Pediatric wide-field fundus photograph. Camera: Phoenix ICON (100° FOV). 1240x1240px.
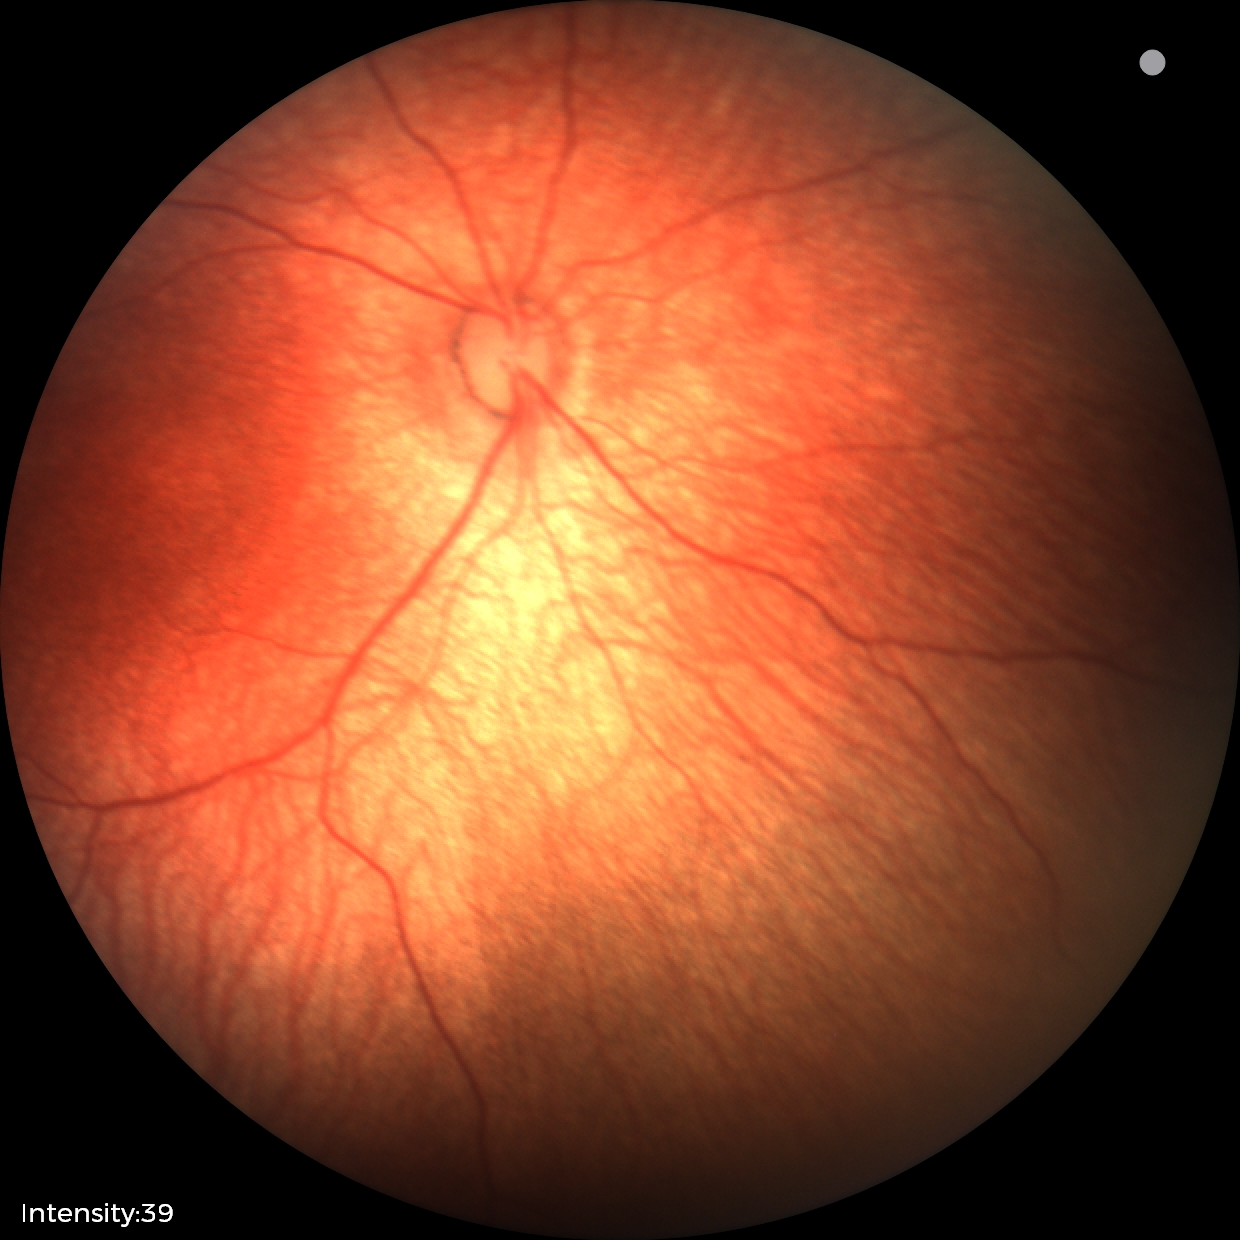
Screening: normal retinal appearance.